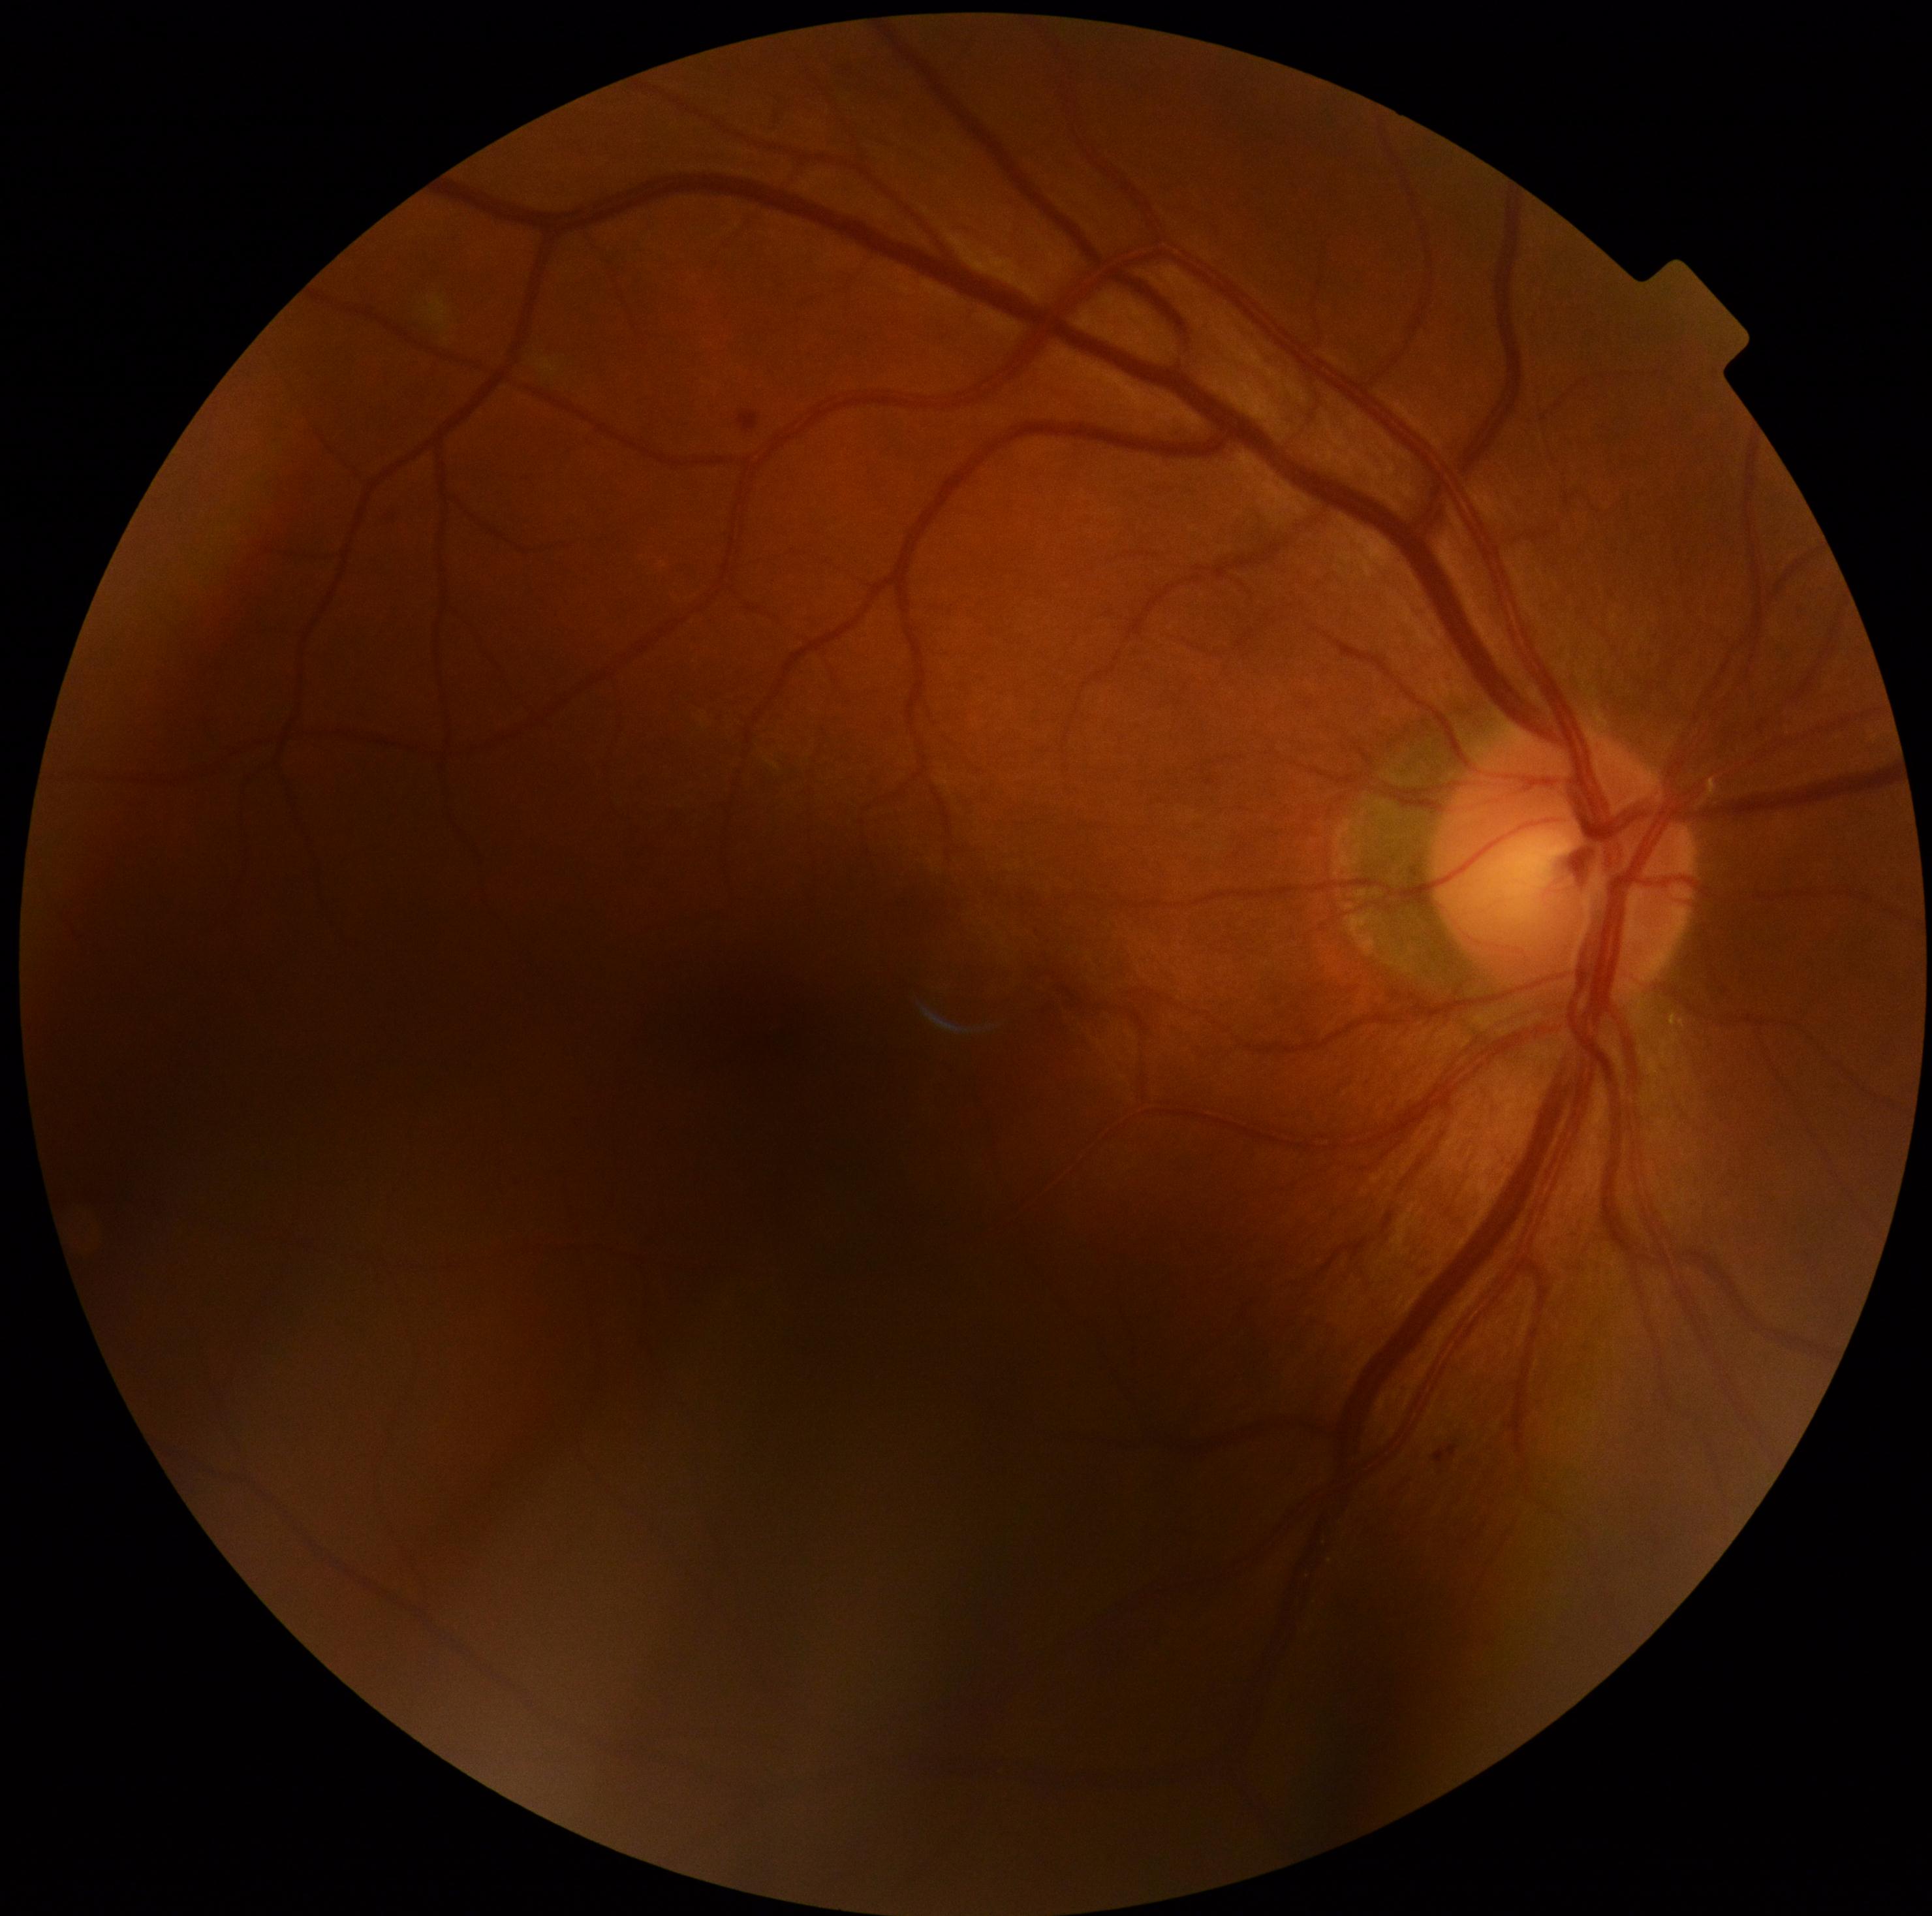
DR is grade 1 (mild NPDR).